Retinal fundus photograph; 2352 x 1568 pixels: 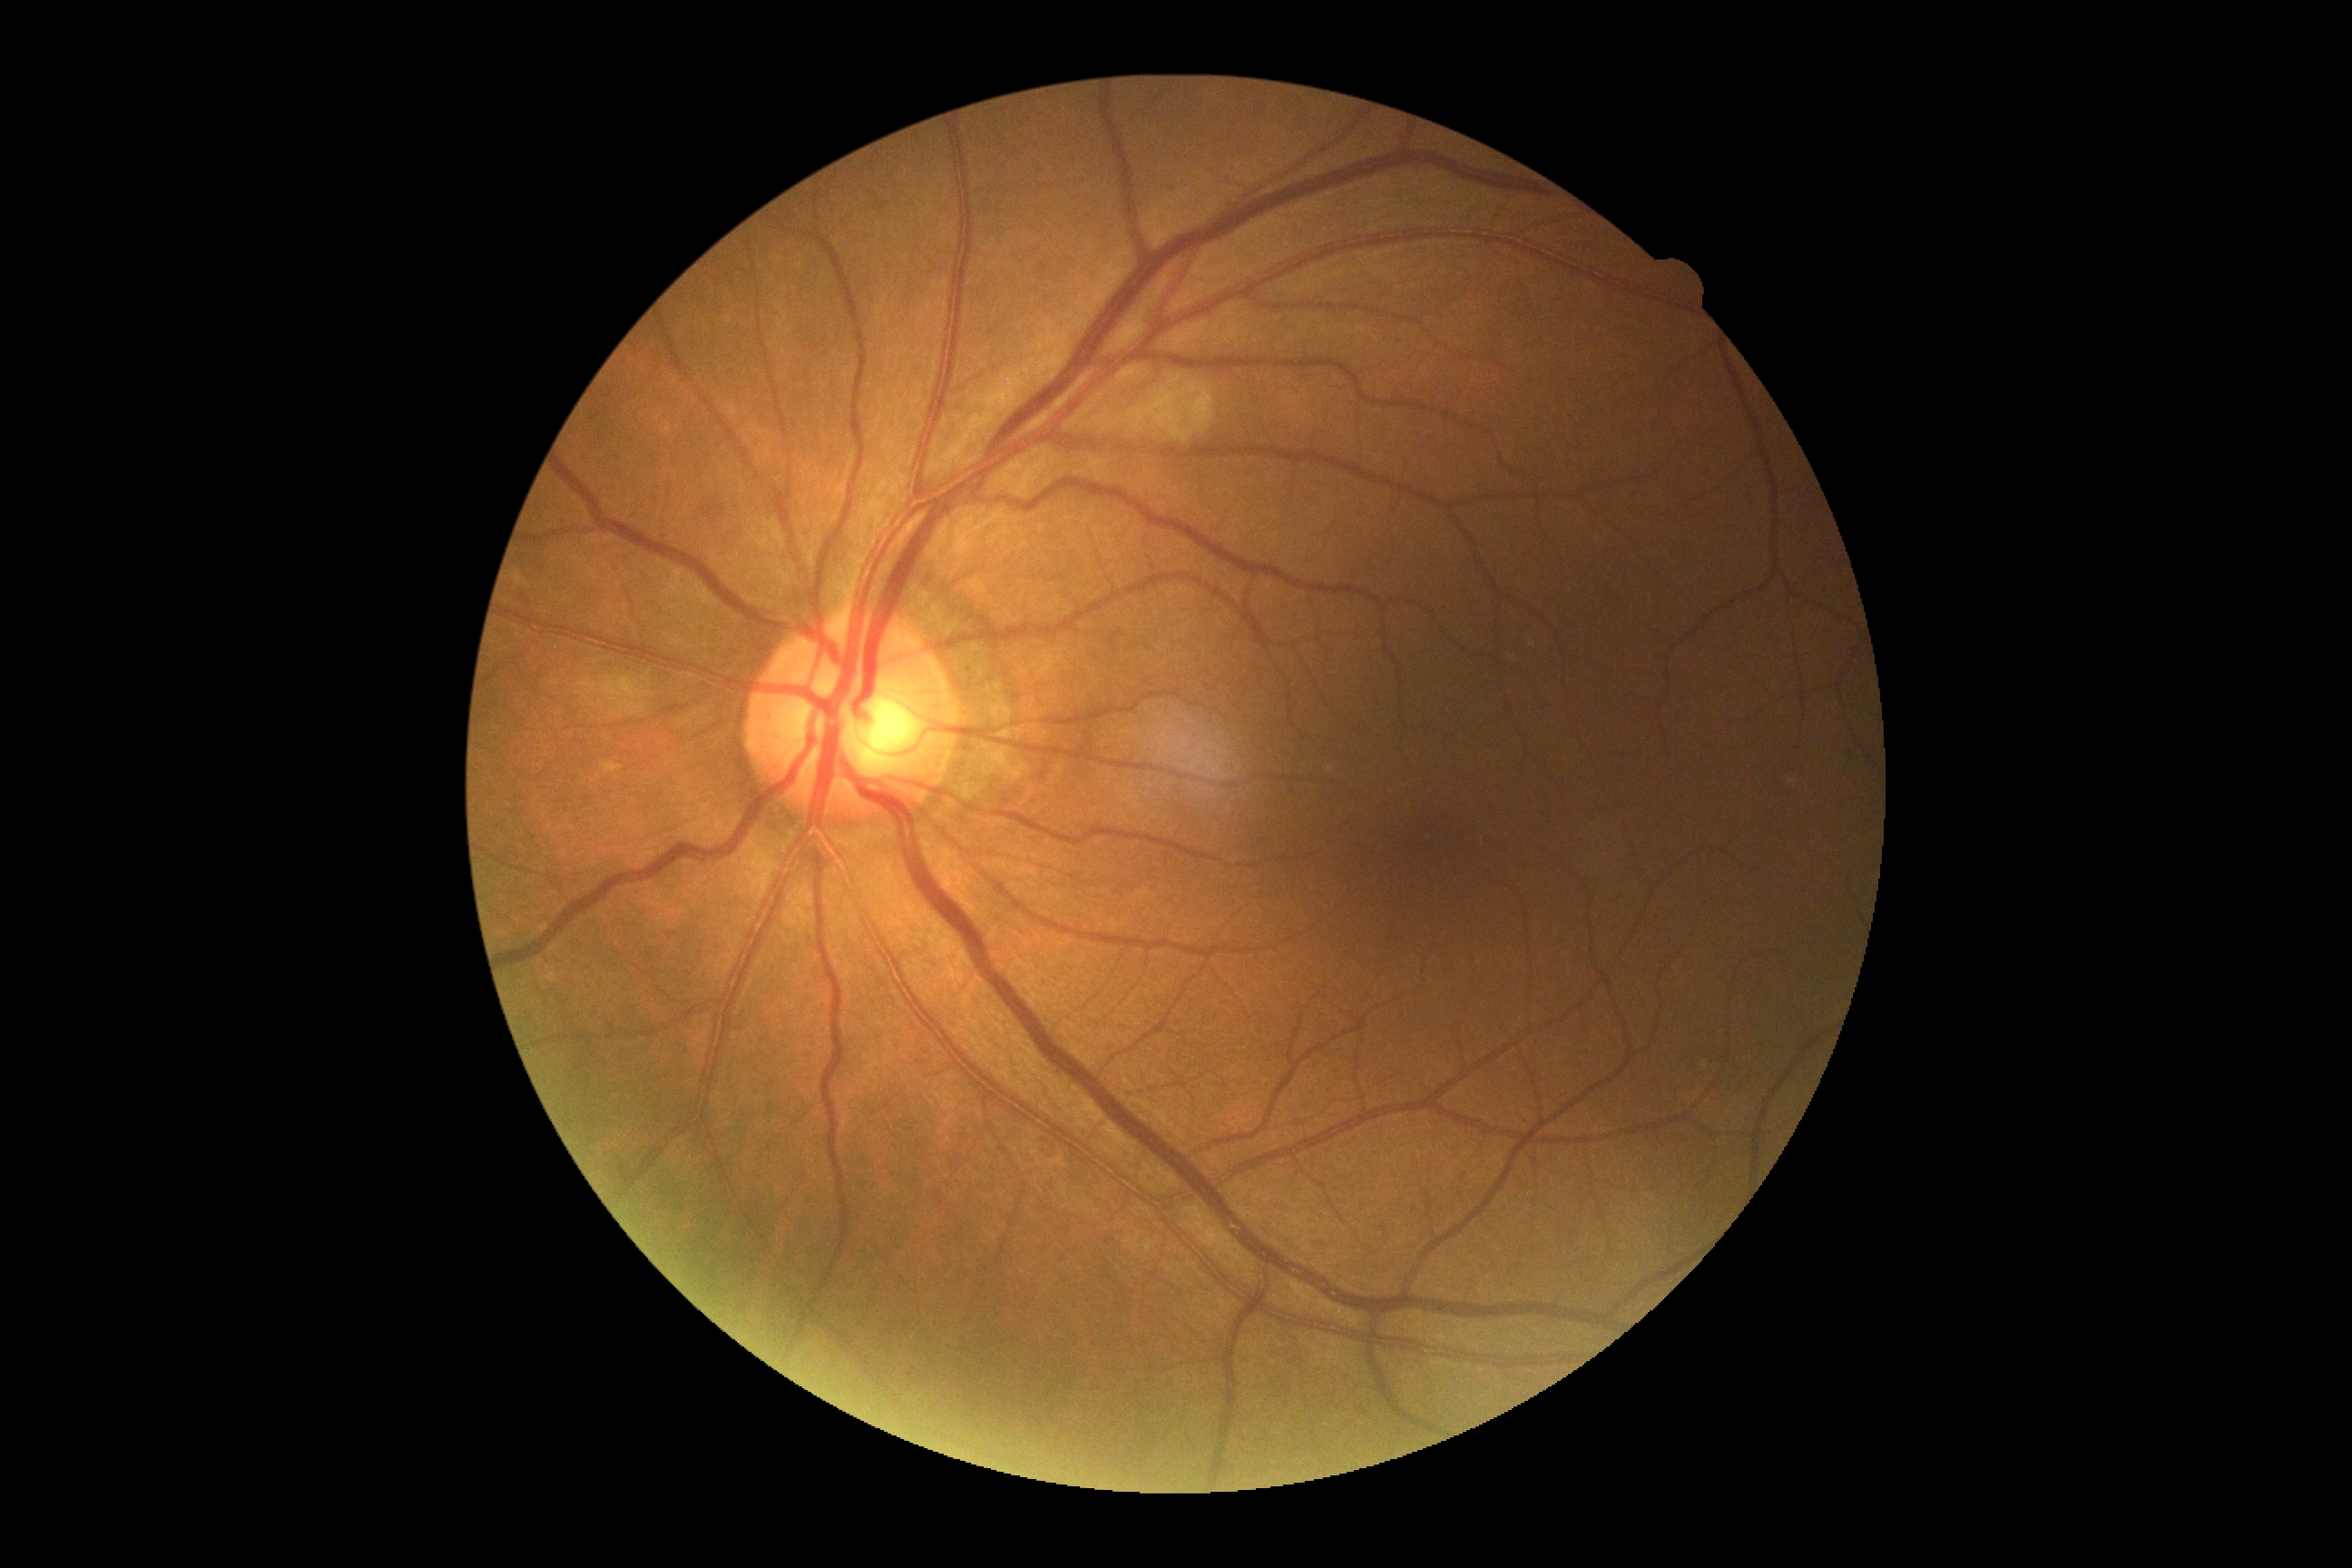
diabetic retinopathy grade: no apparent retinopathy (0) — no visible signs of diabetic retinopathy.